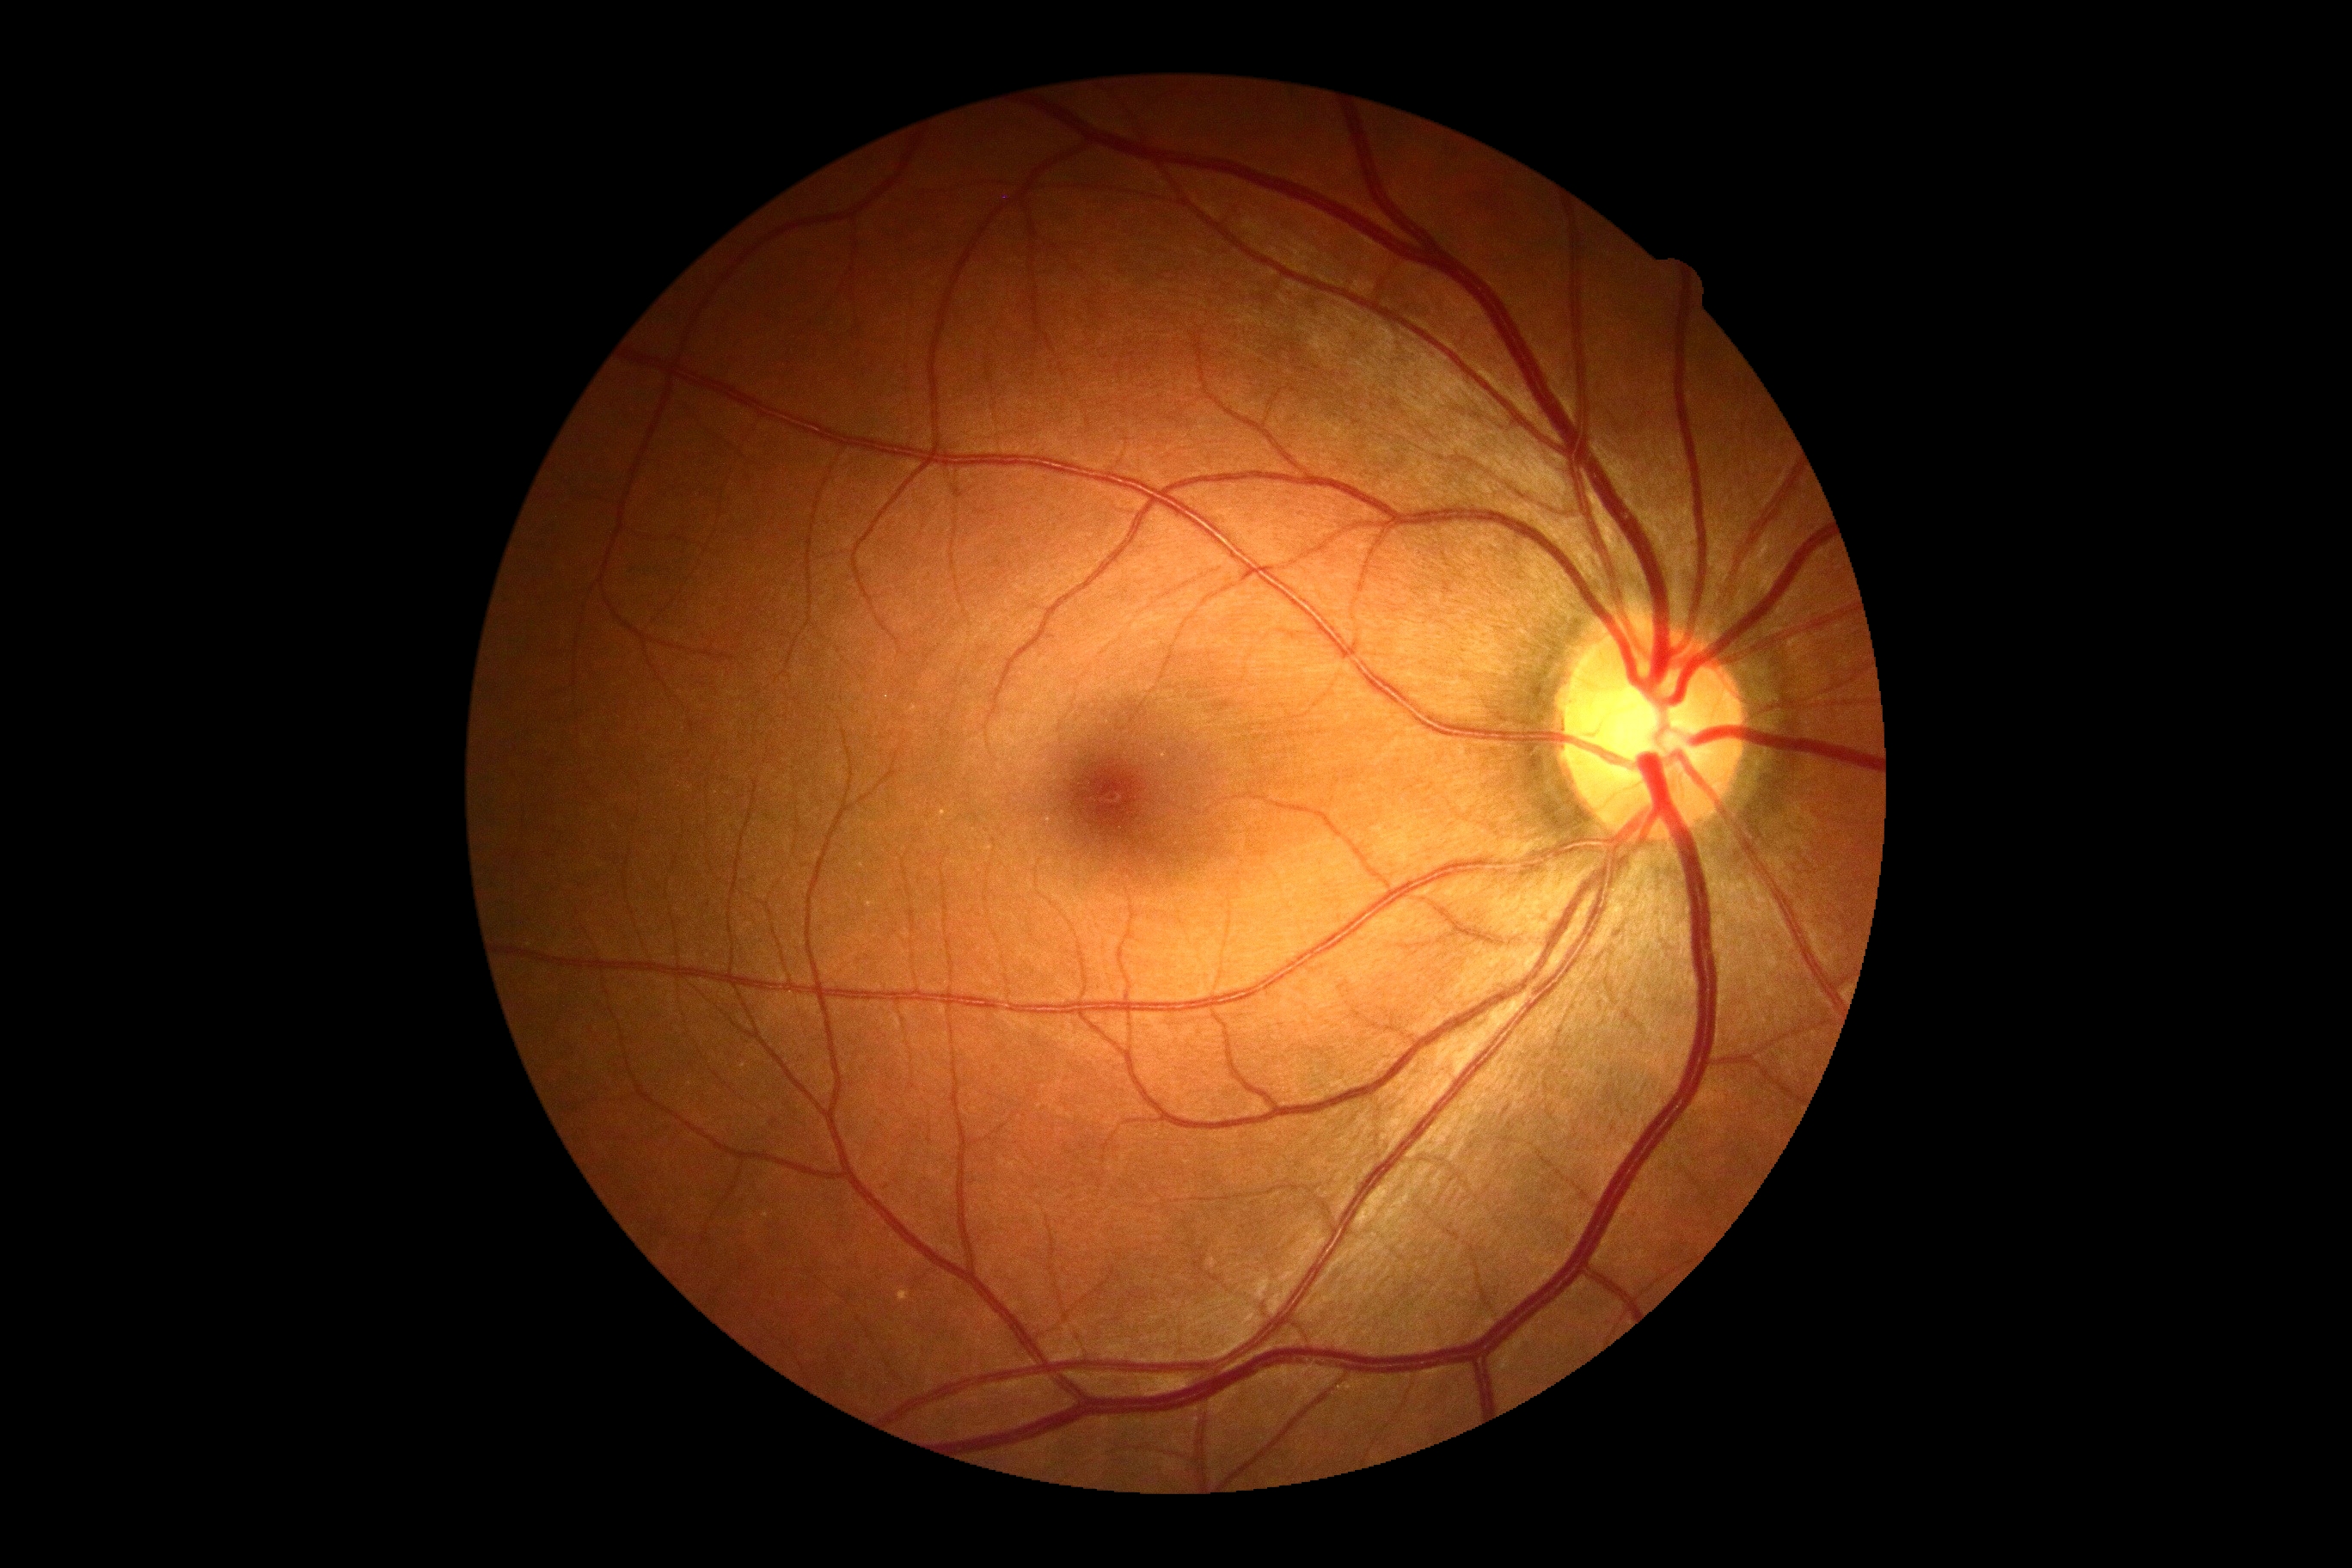 DR stage: 0 — no visible signs of diabetic retinopathy. No signs of diabetic retinopathy.